Infant wide-field fundus photograph
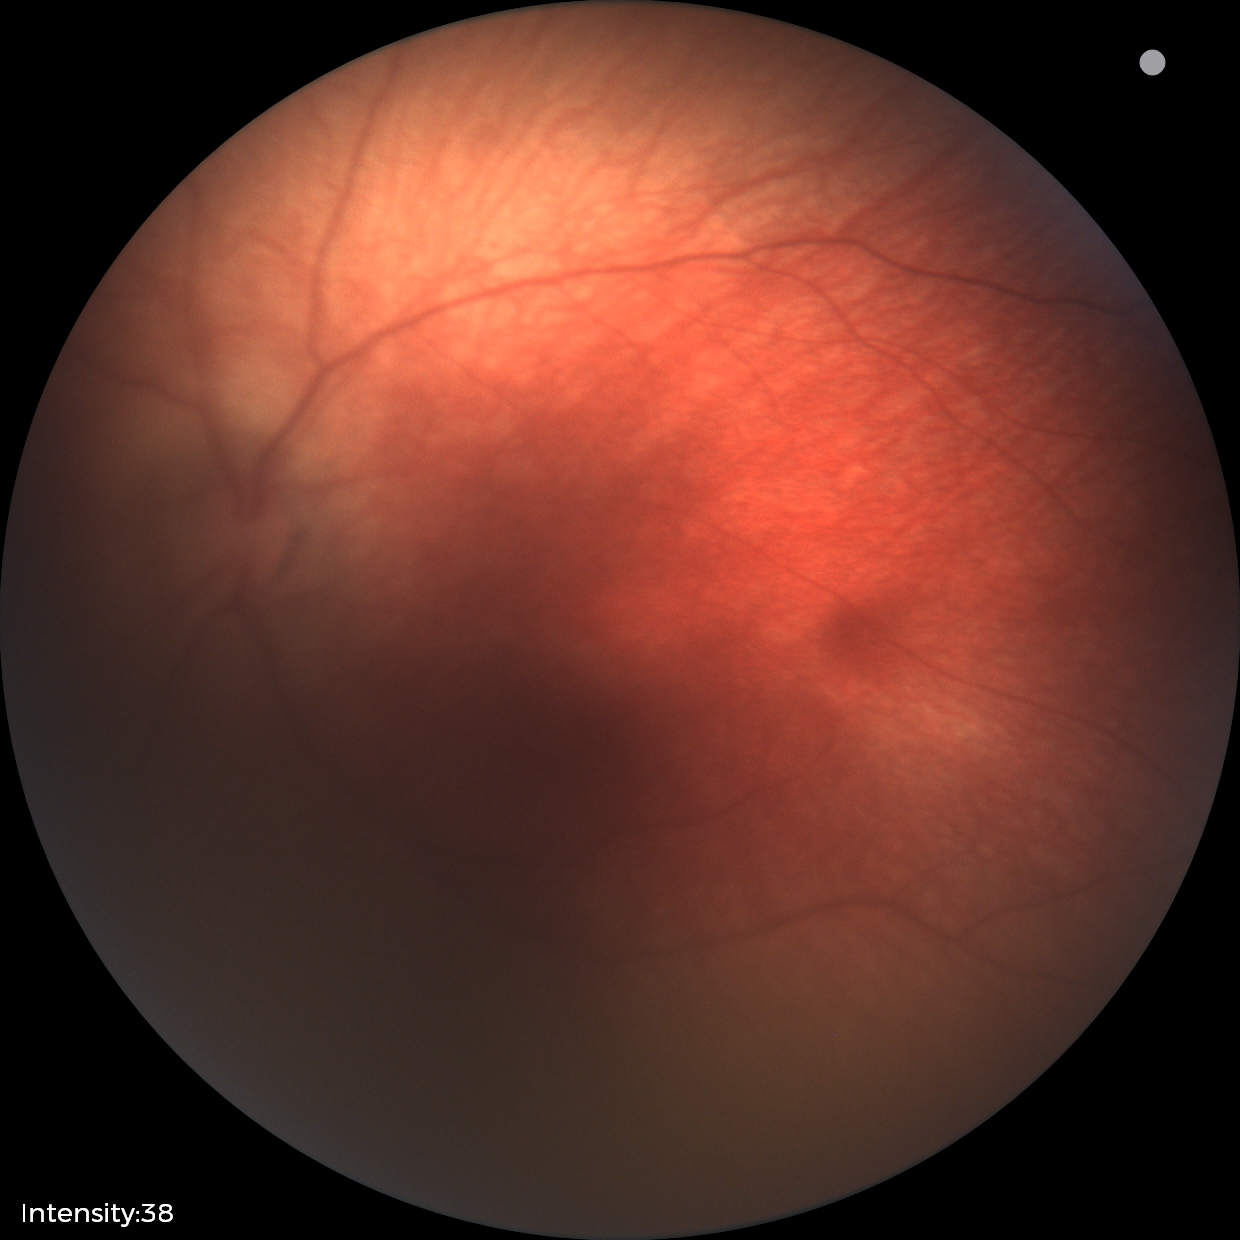 Physiological retinal appearance for postconceptual age.